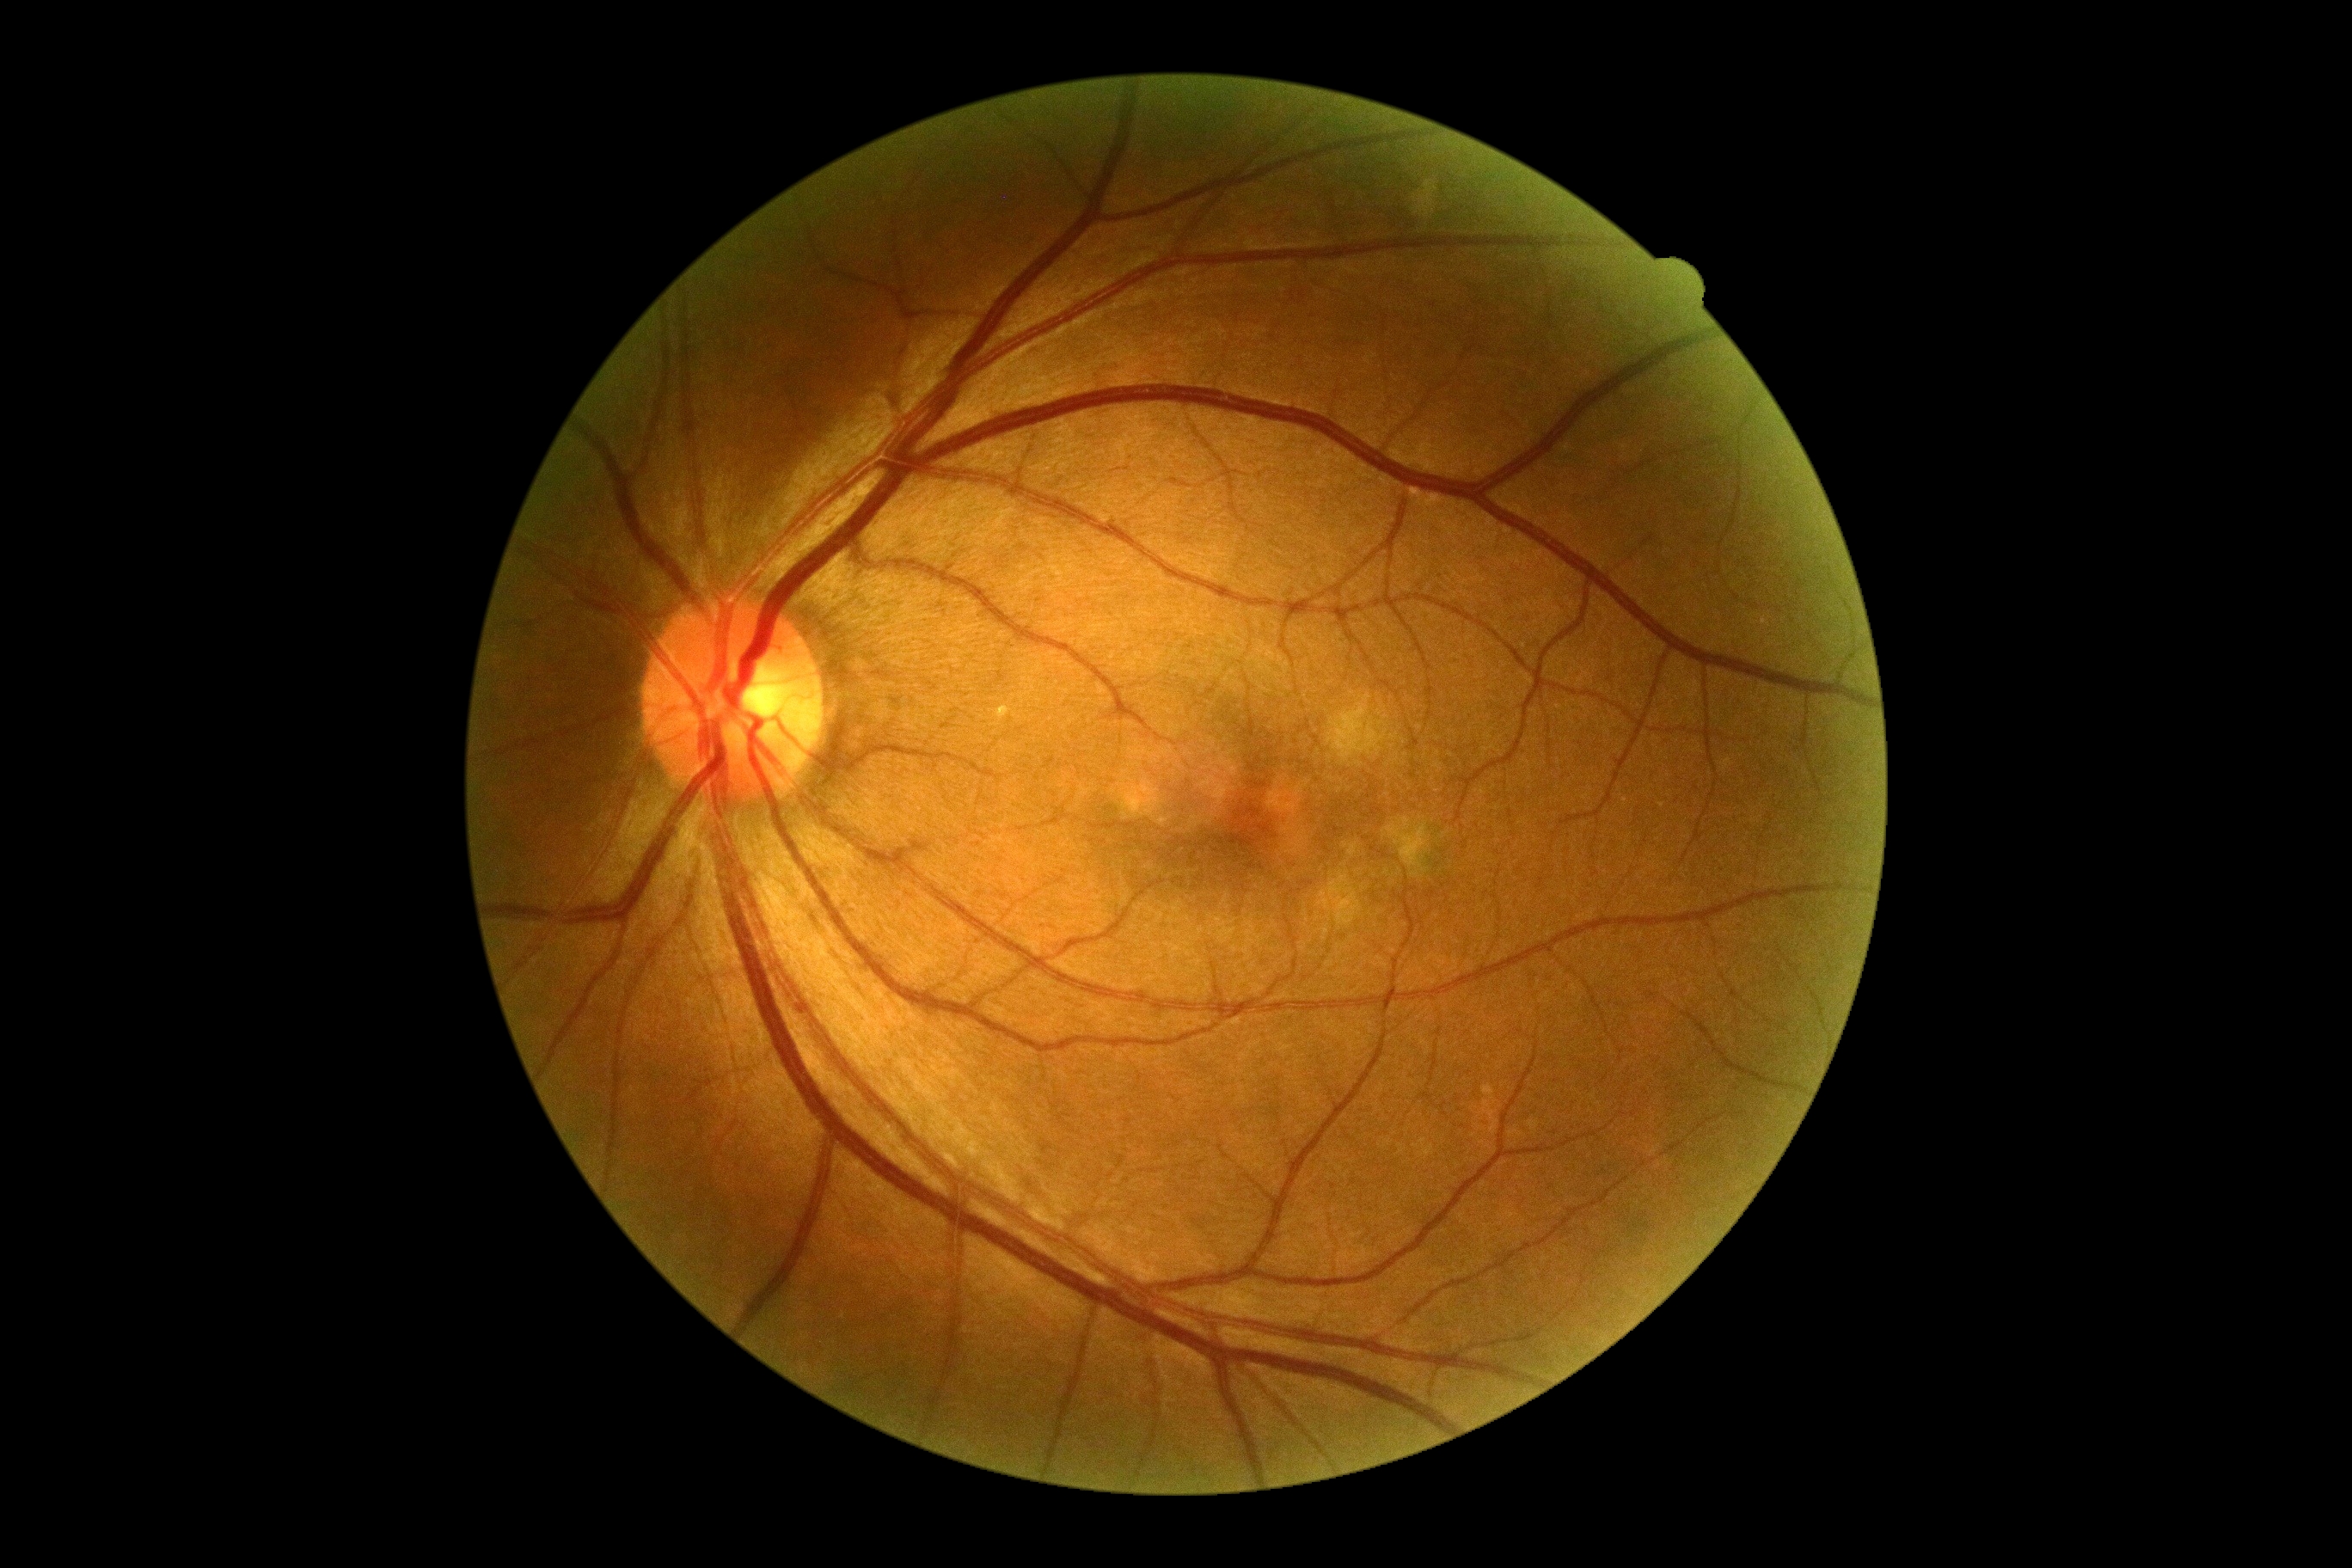 {"dr_grade": "0"}